45° FOV:
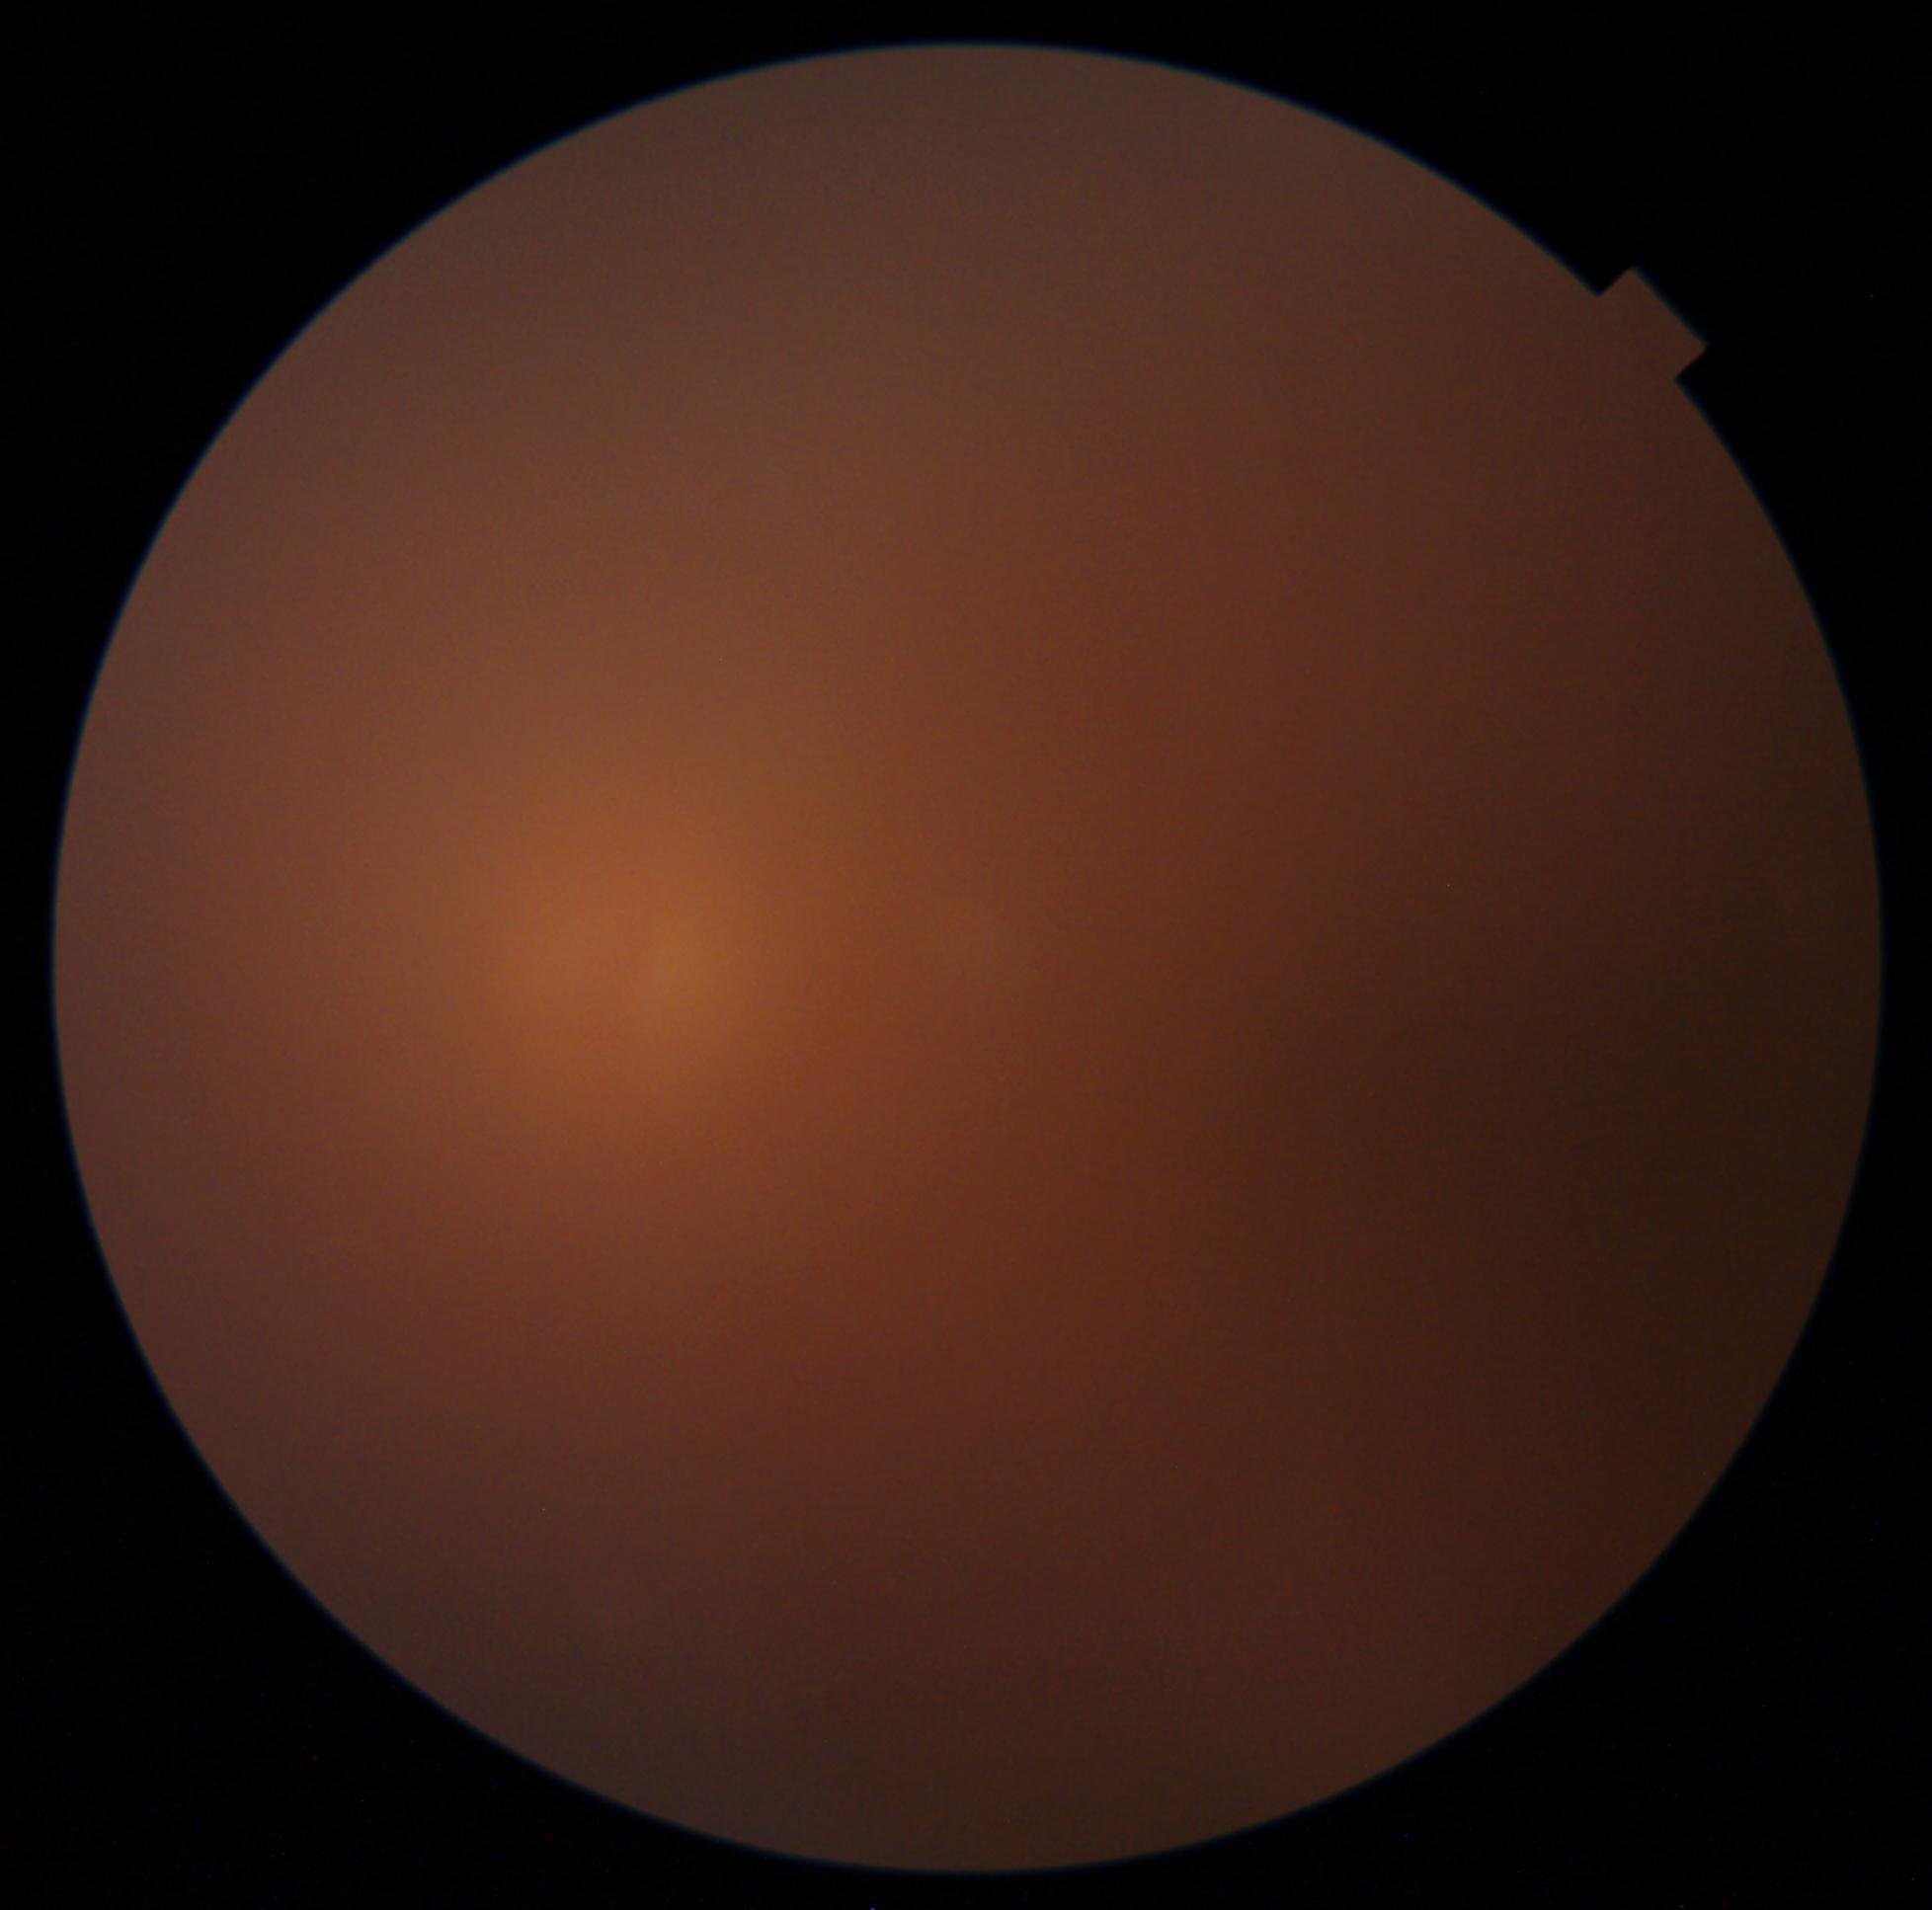 DR grade: ungradable due to poor image quality.